Nonmydriatic; image size 848x848; Davis DR grading.
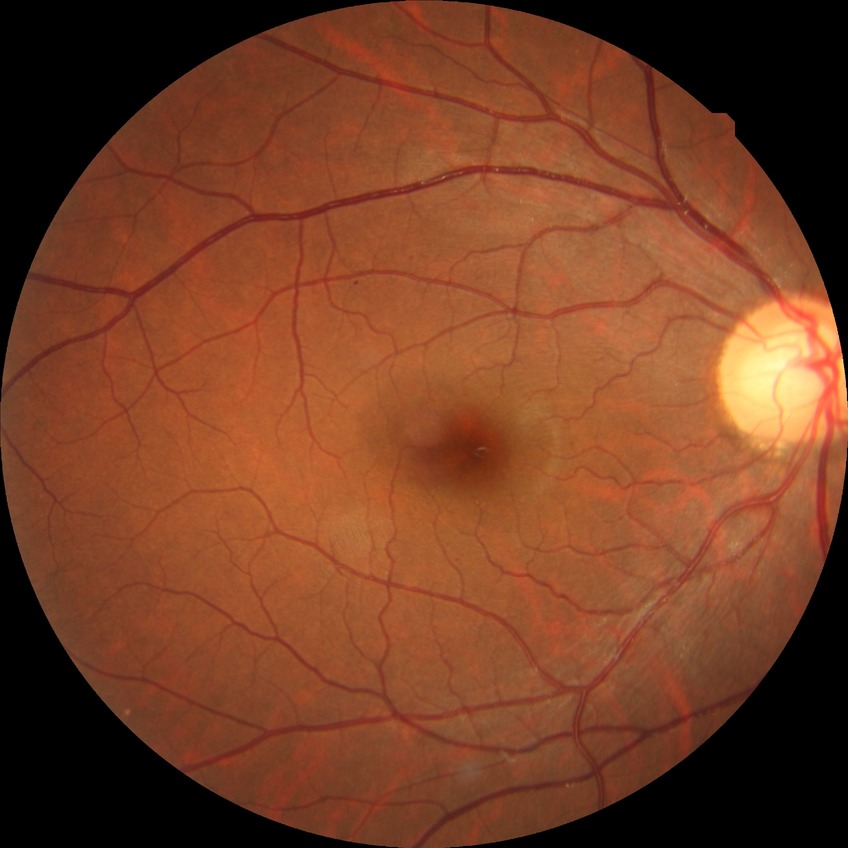

{
  "davis_grade": "simple diabetic retinopathy (SDR)"
}